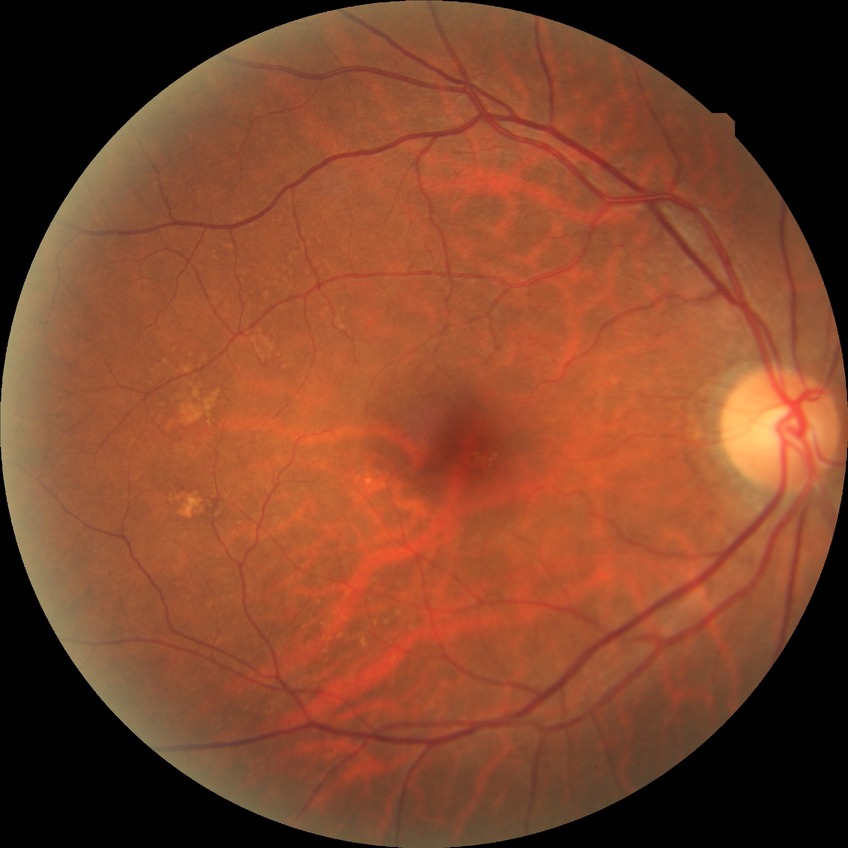
Retinopathy grade: no diabetic retinopathy.